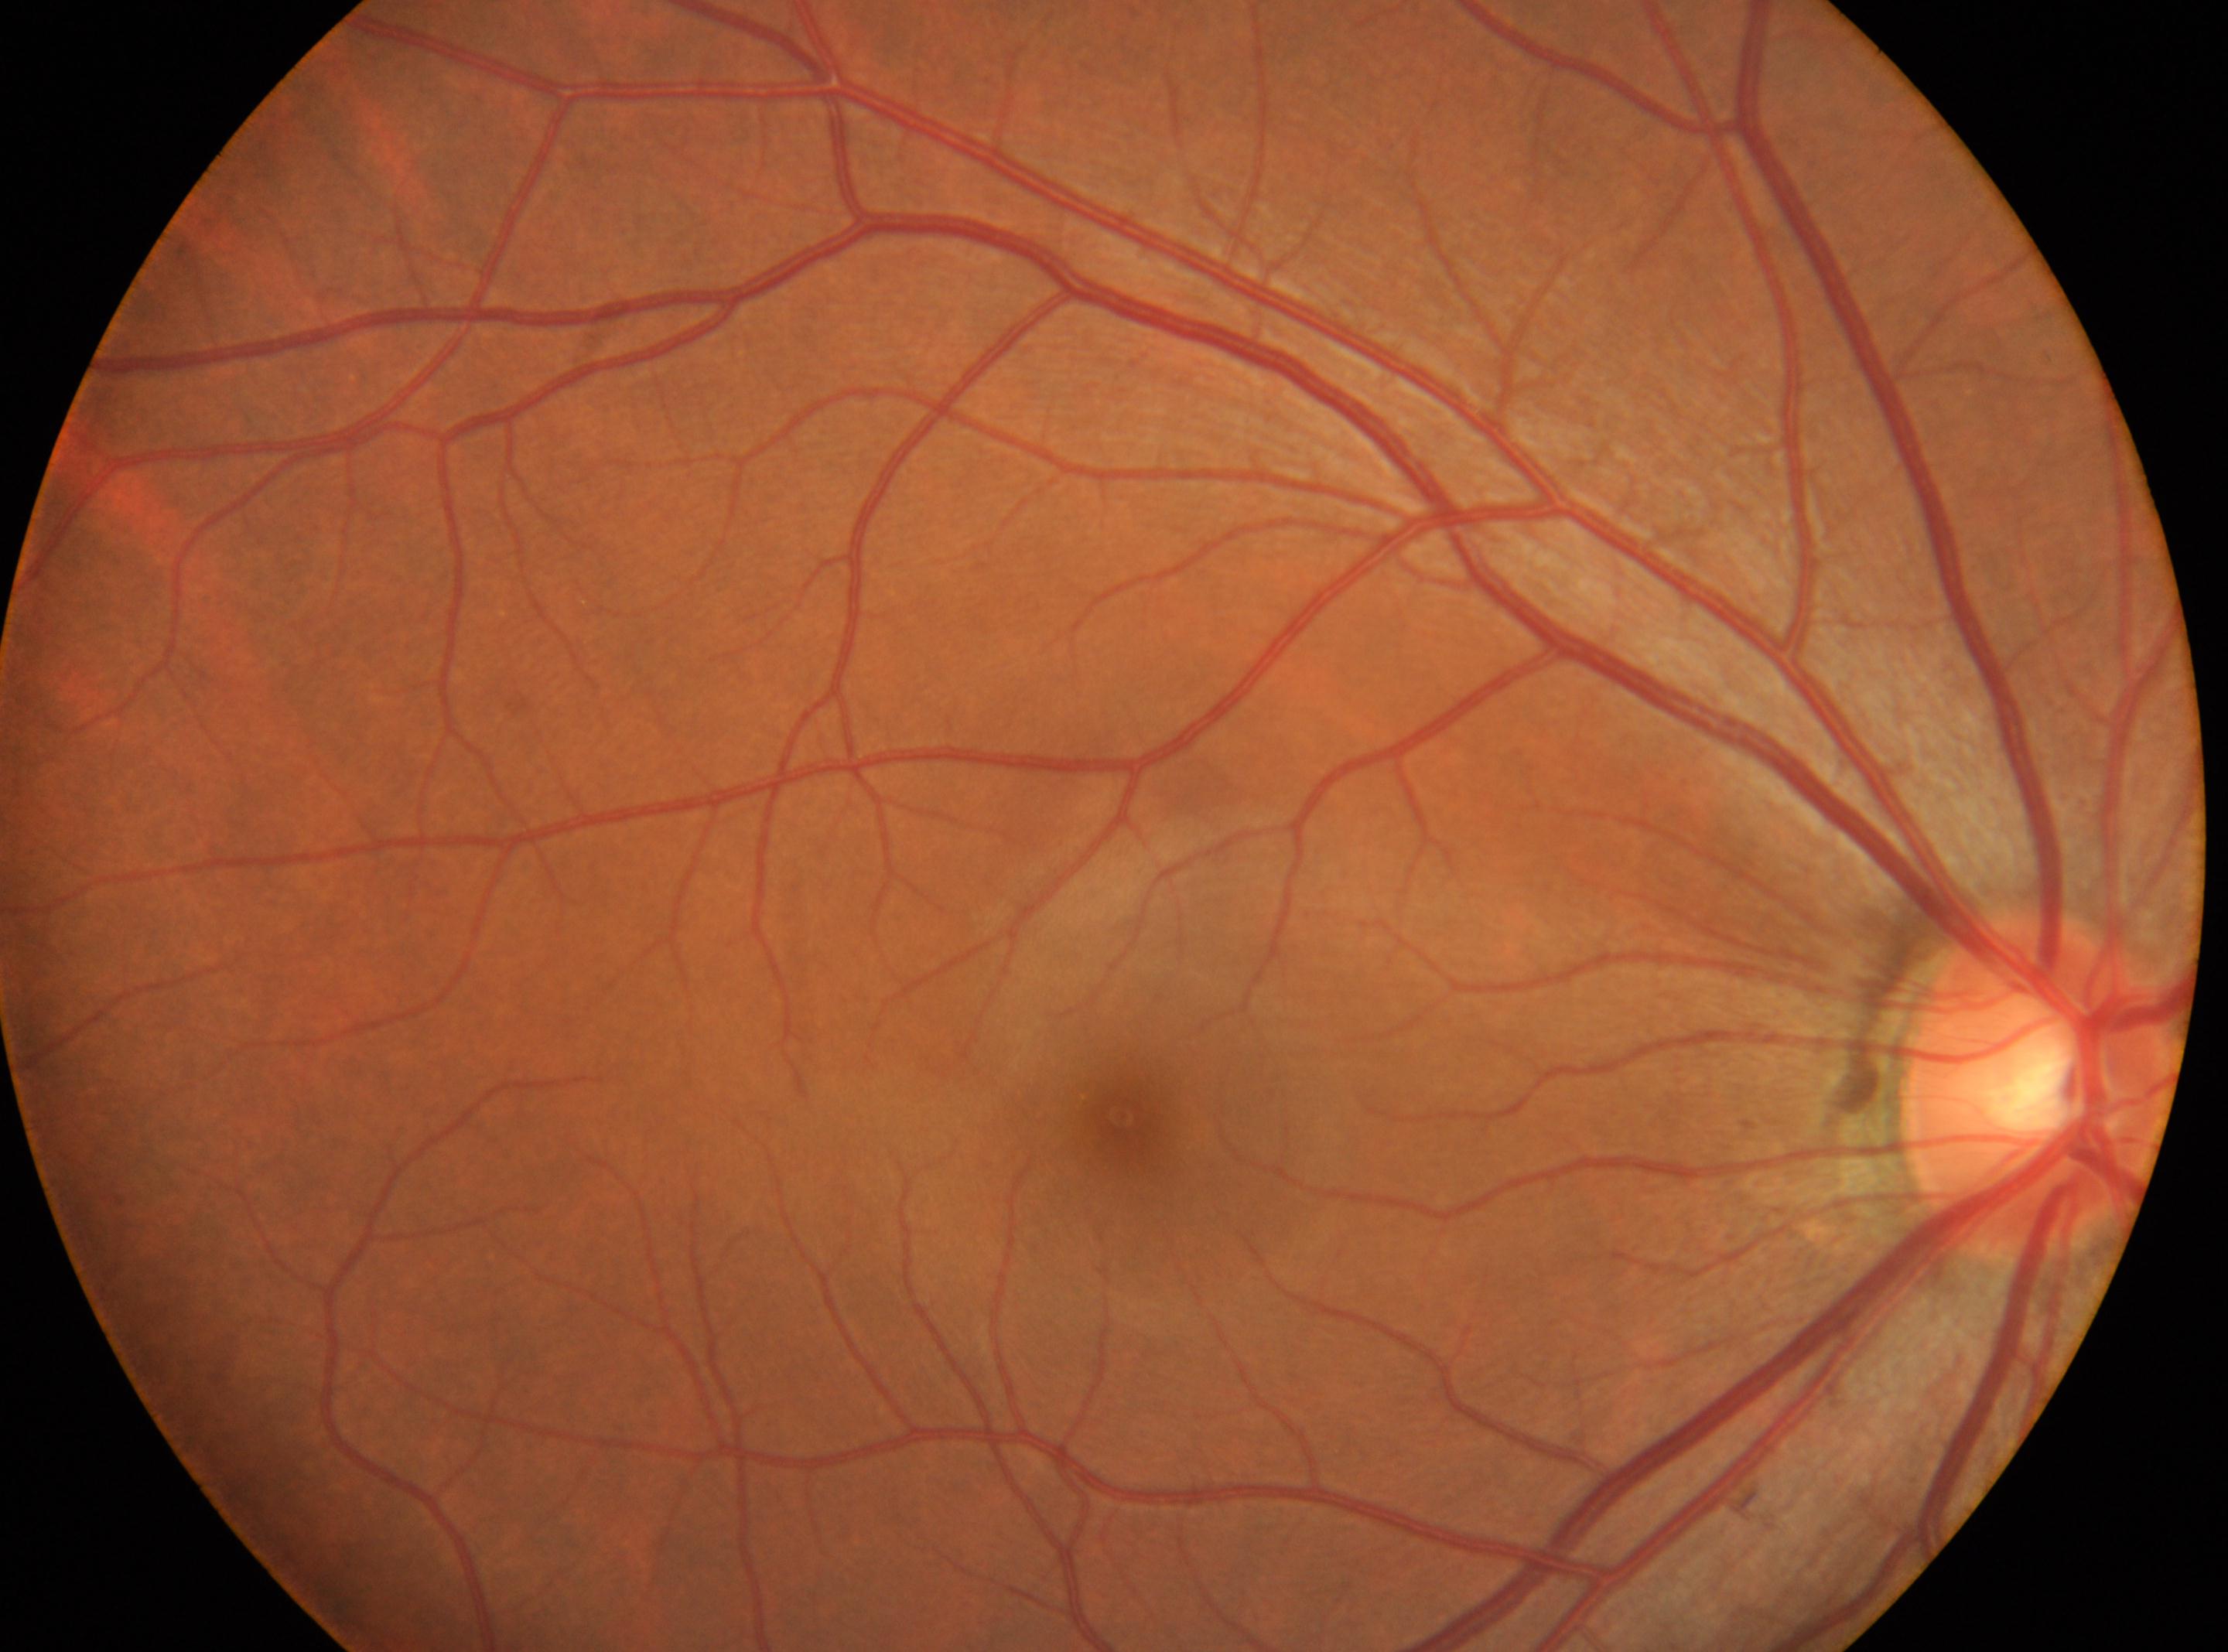

The image shows the right eye.
Fovea center located at [1122, 1115].
DR stage: no apparent retinopathy (grade 0).
The optic disc center is at [2038, 1080].